Topcon TRC-NW8; color fundus photograph.
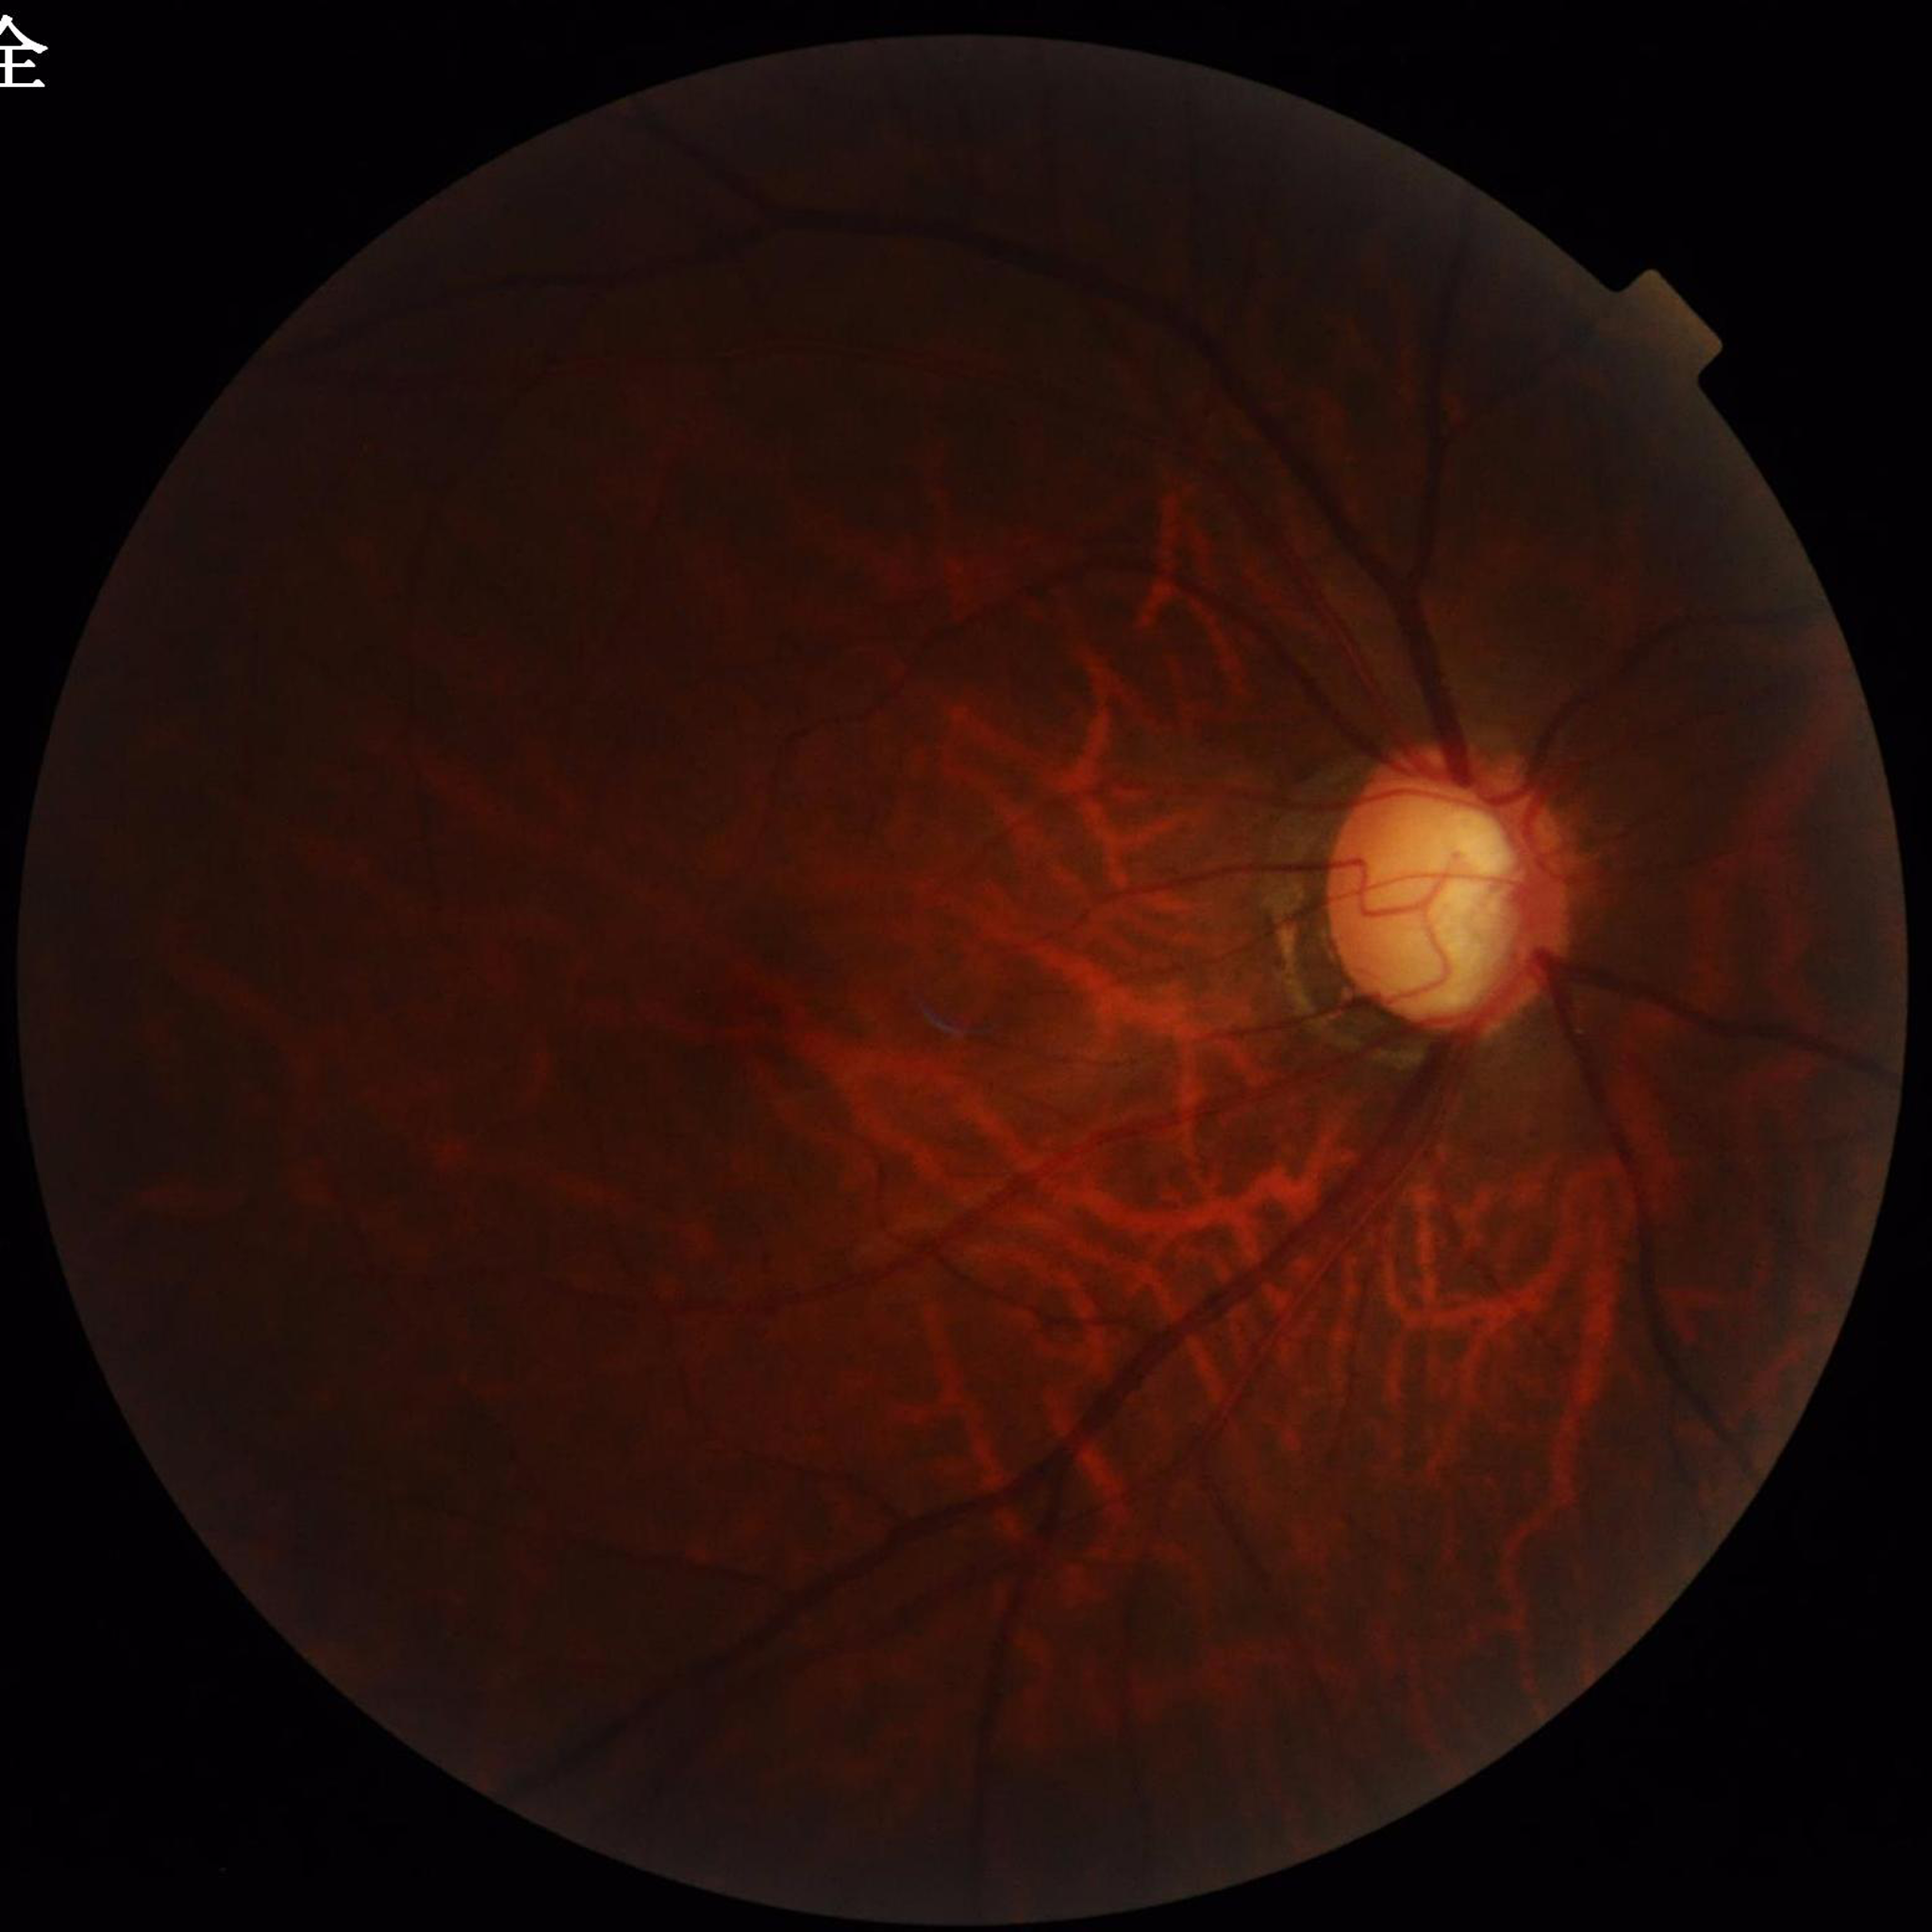

Impression: glaucoma | Automated quality assessment: suboptimal — illumination/color distortion, blur.